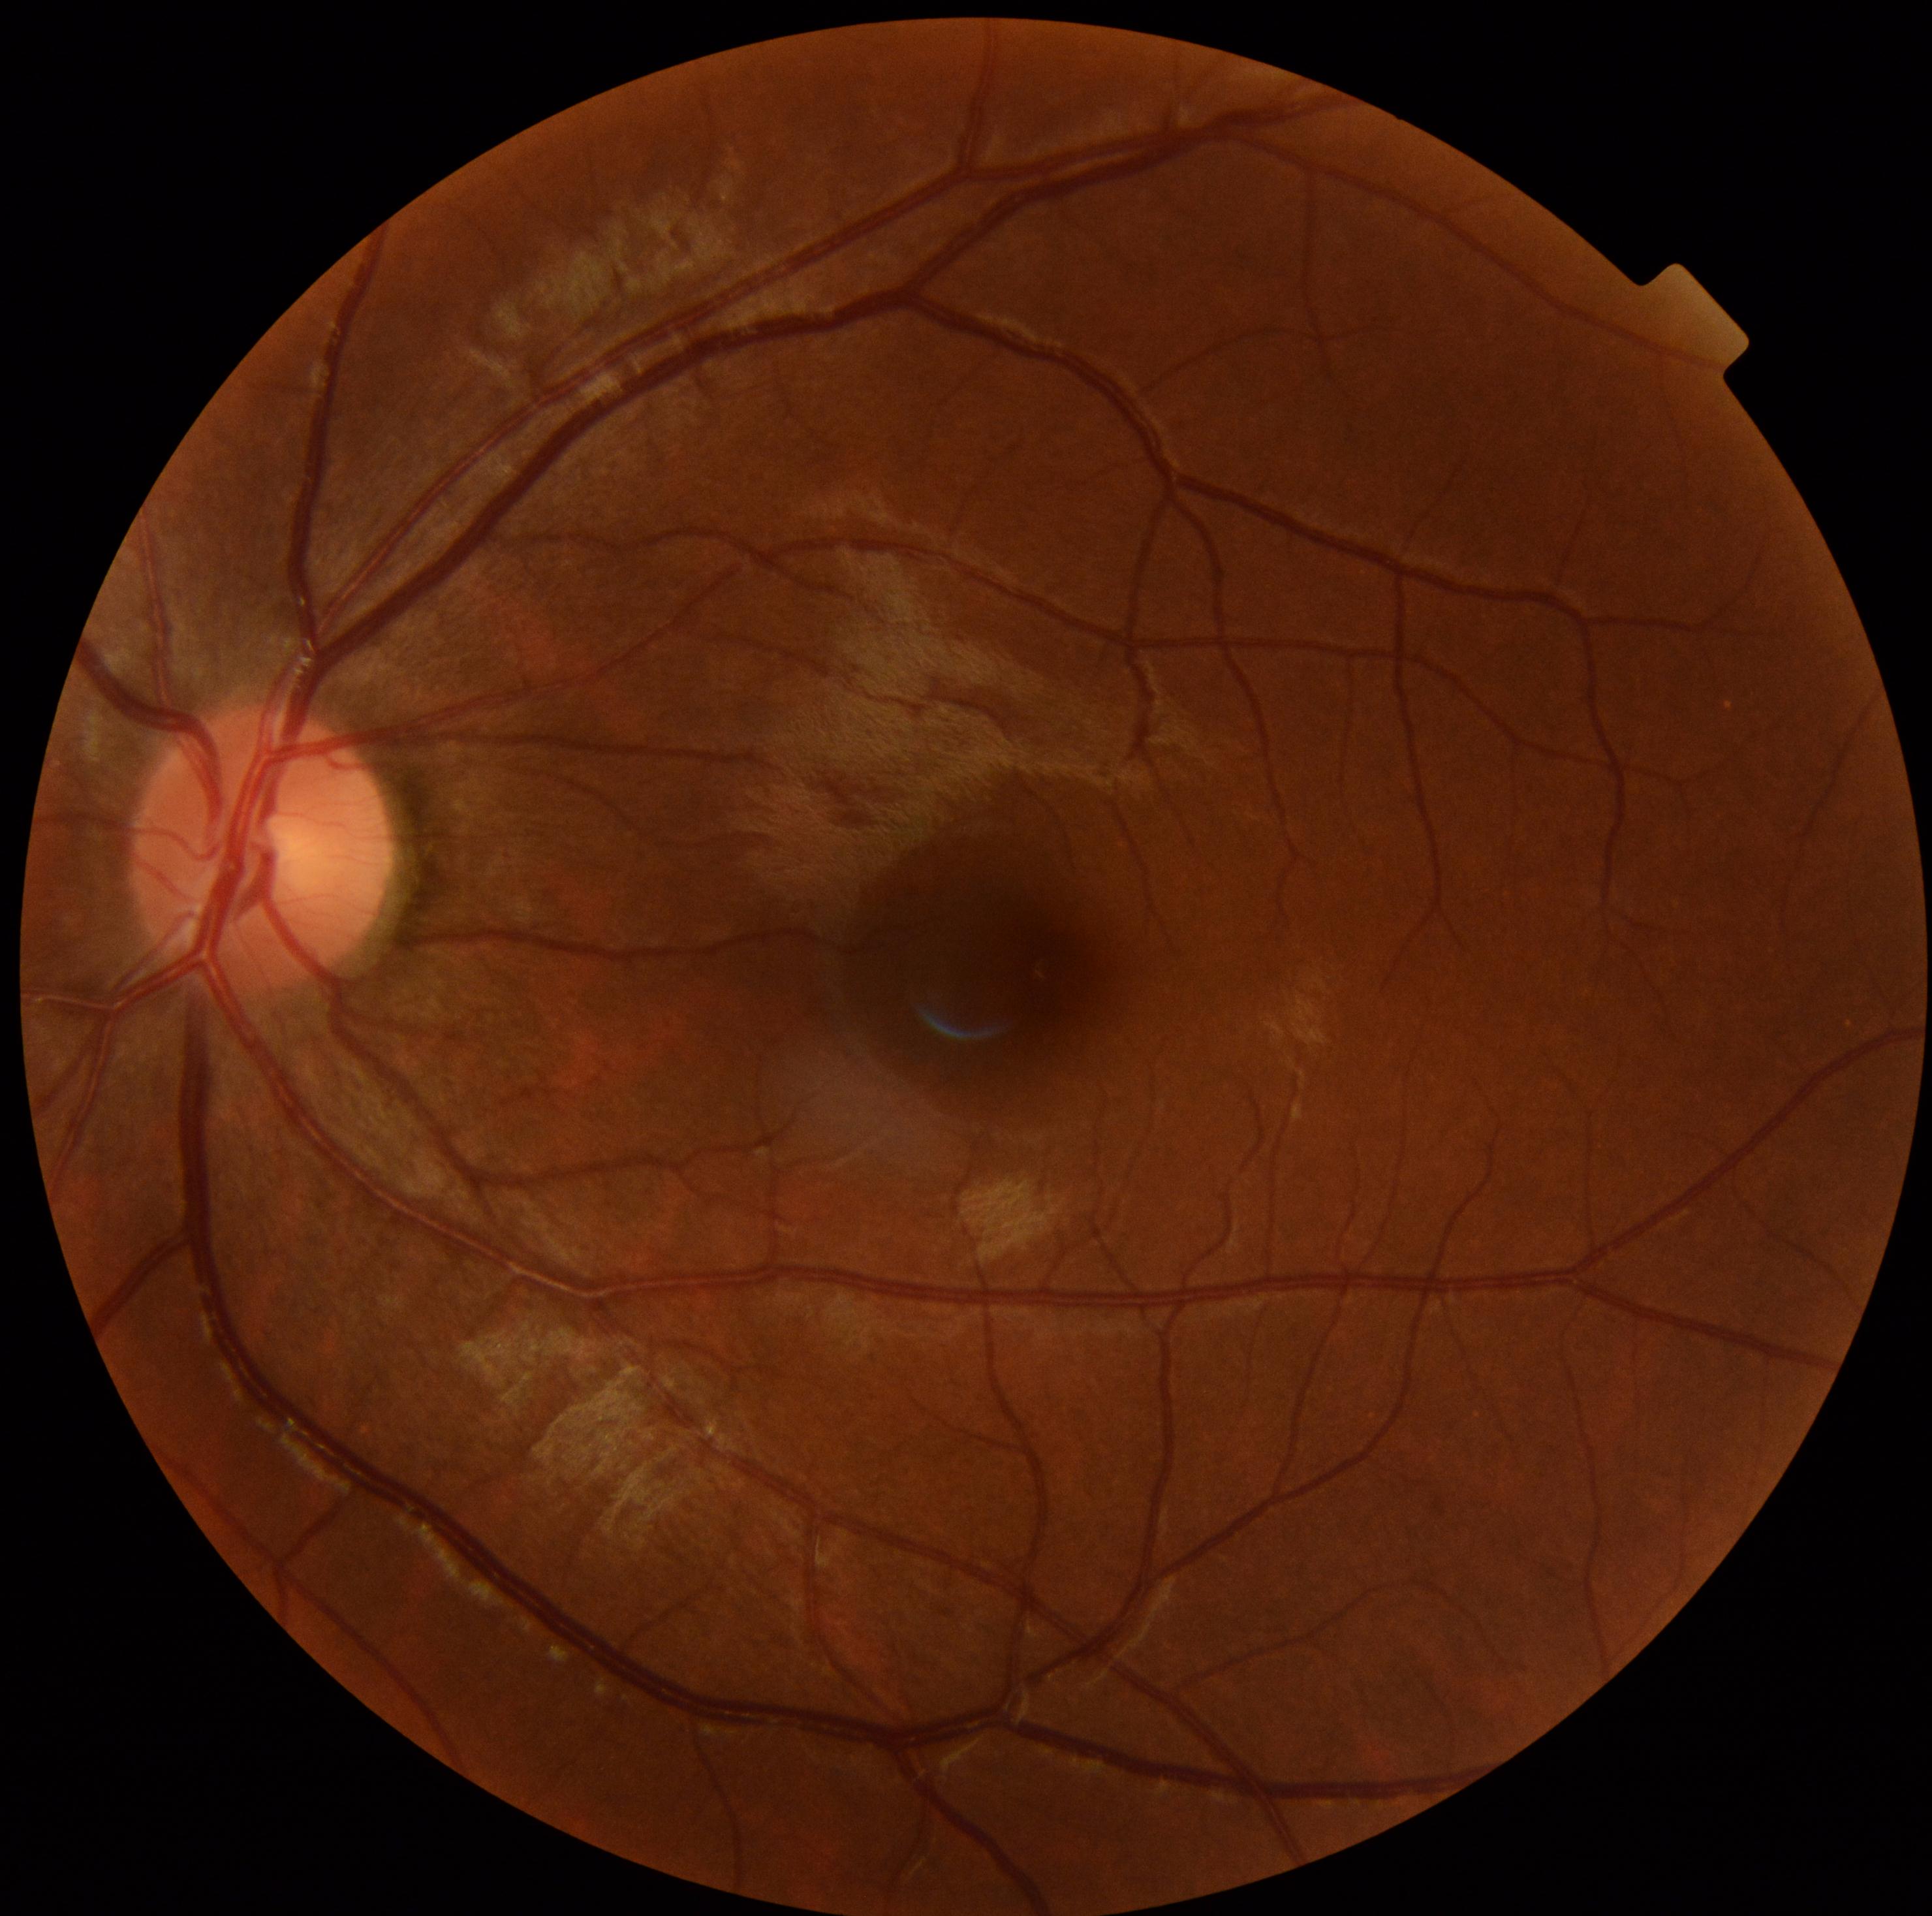 Retinopathy: no apparent retinopathy (grade 0).